Wide-field fundus image from infant ROP screening: 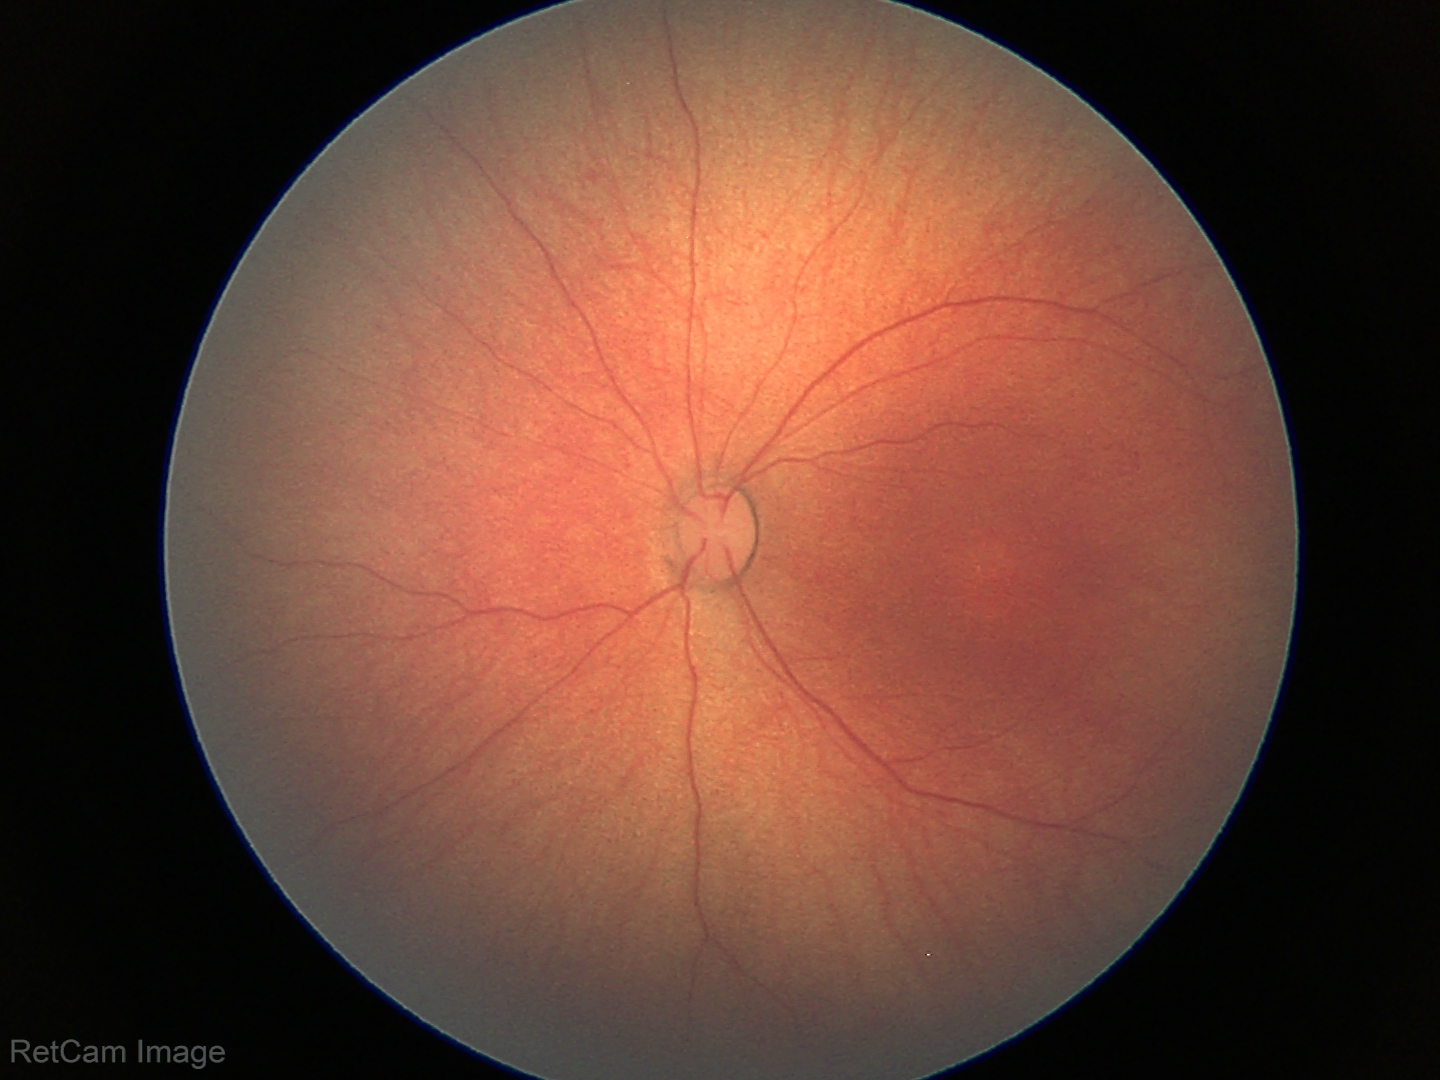
Examination with physiological retinal findings.